100° field of view (Phoenix ICON). Wide-field fundus image from infant ROP screening. 1240 x 1240 pixels — 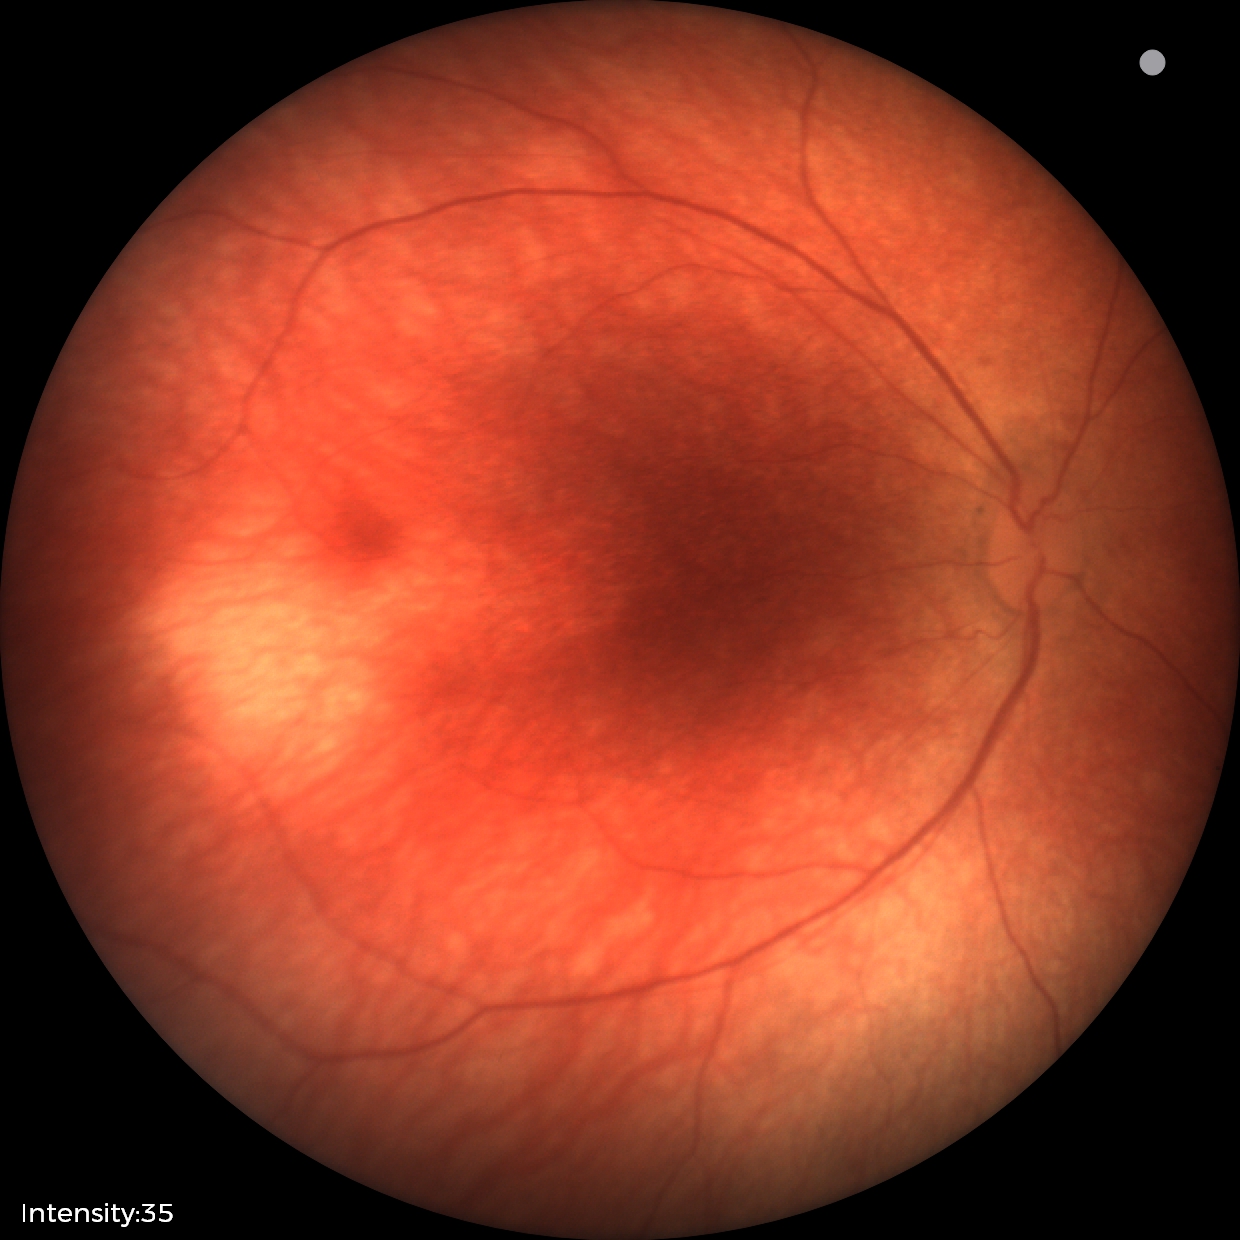 Diagnosis = no pathology identified